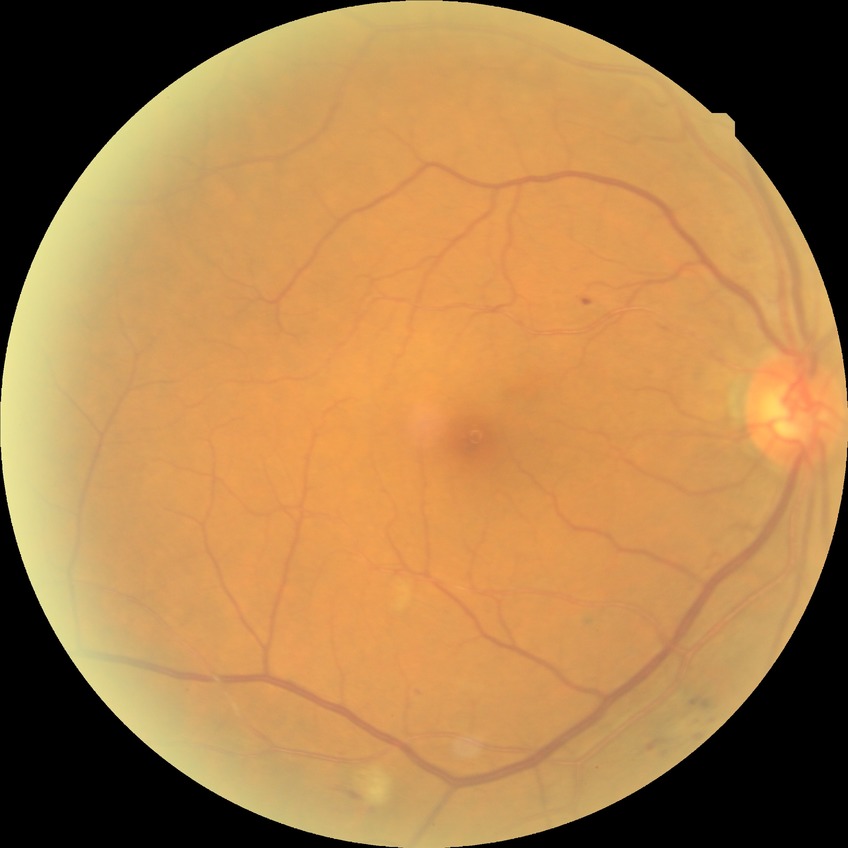
davis_grade: simple diabetic retinopathy